45-degree field of view.
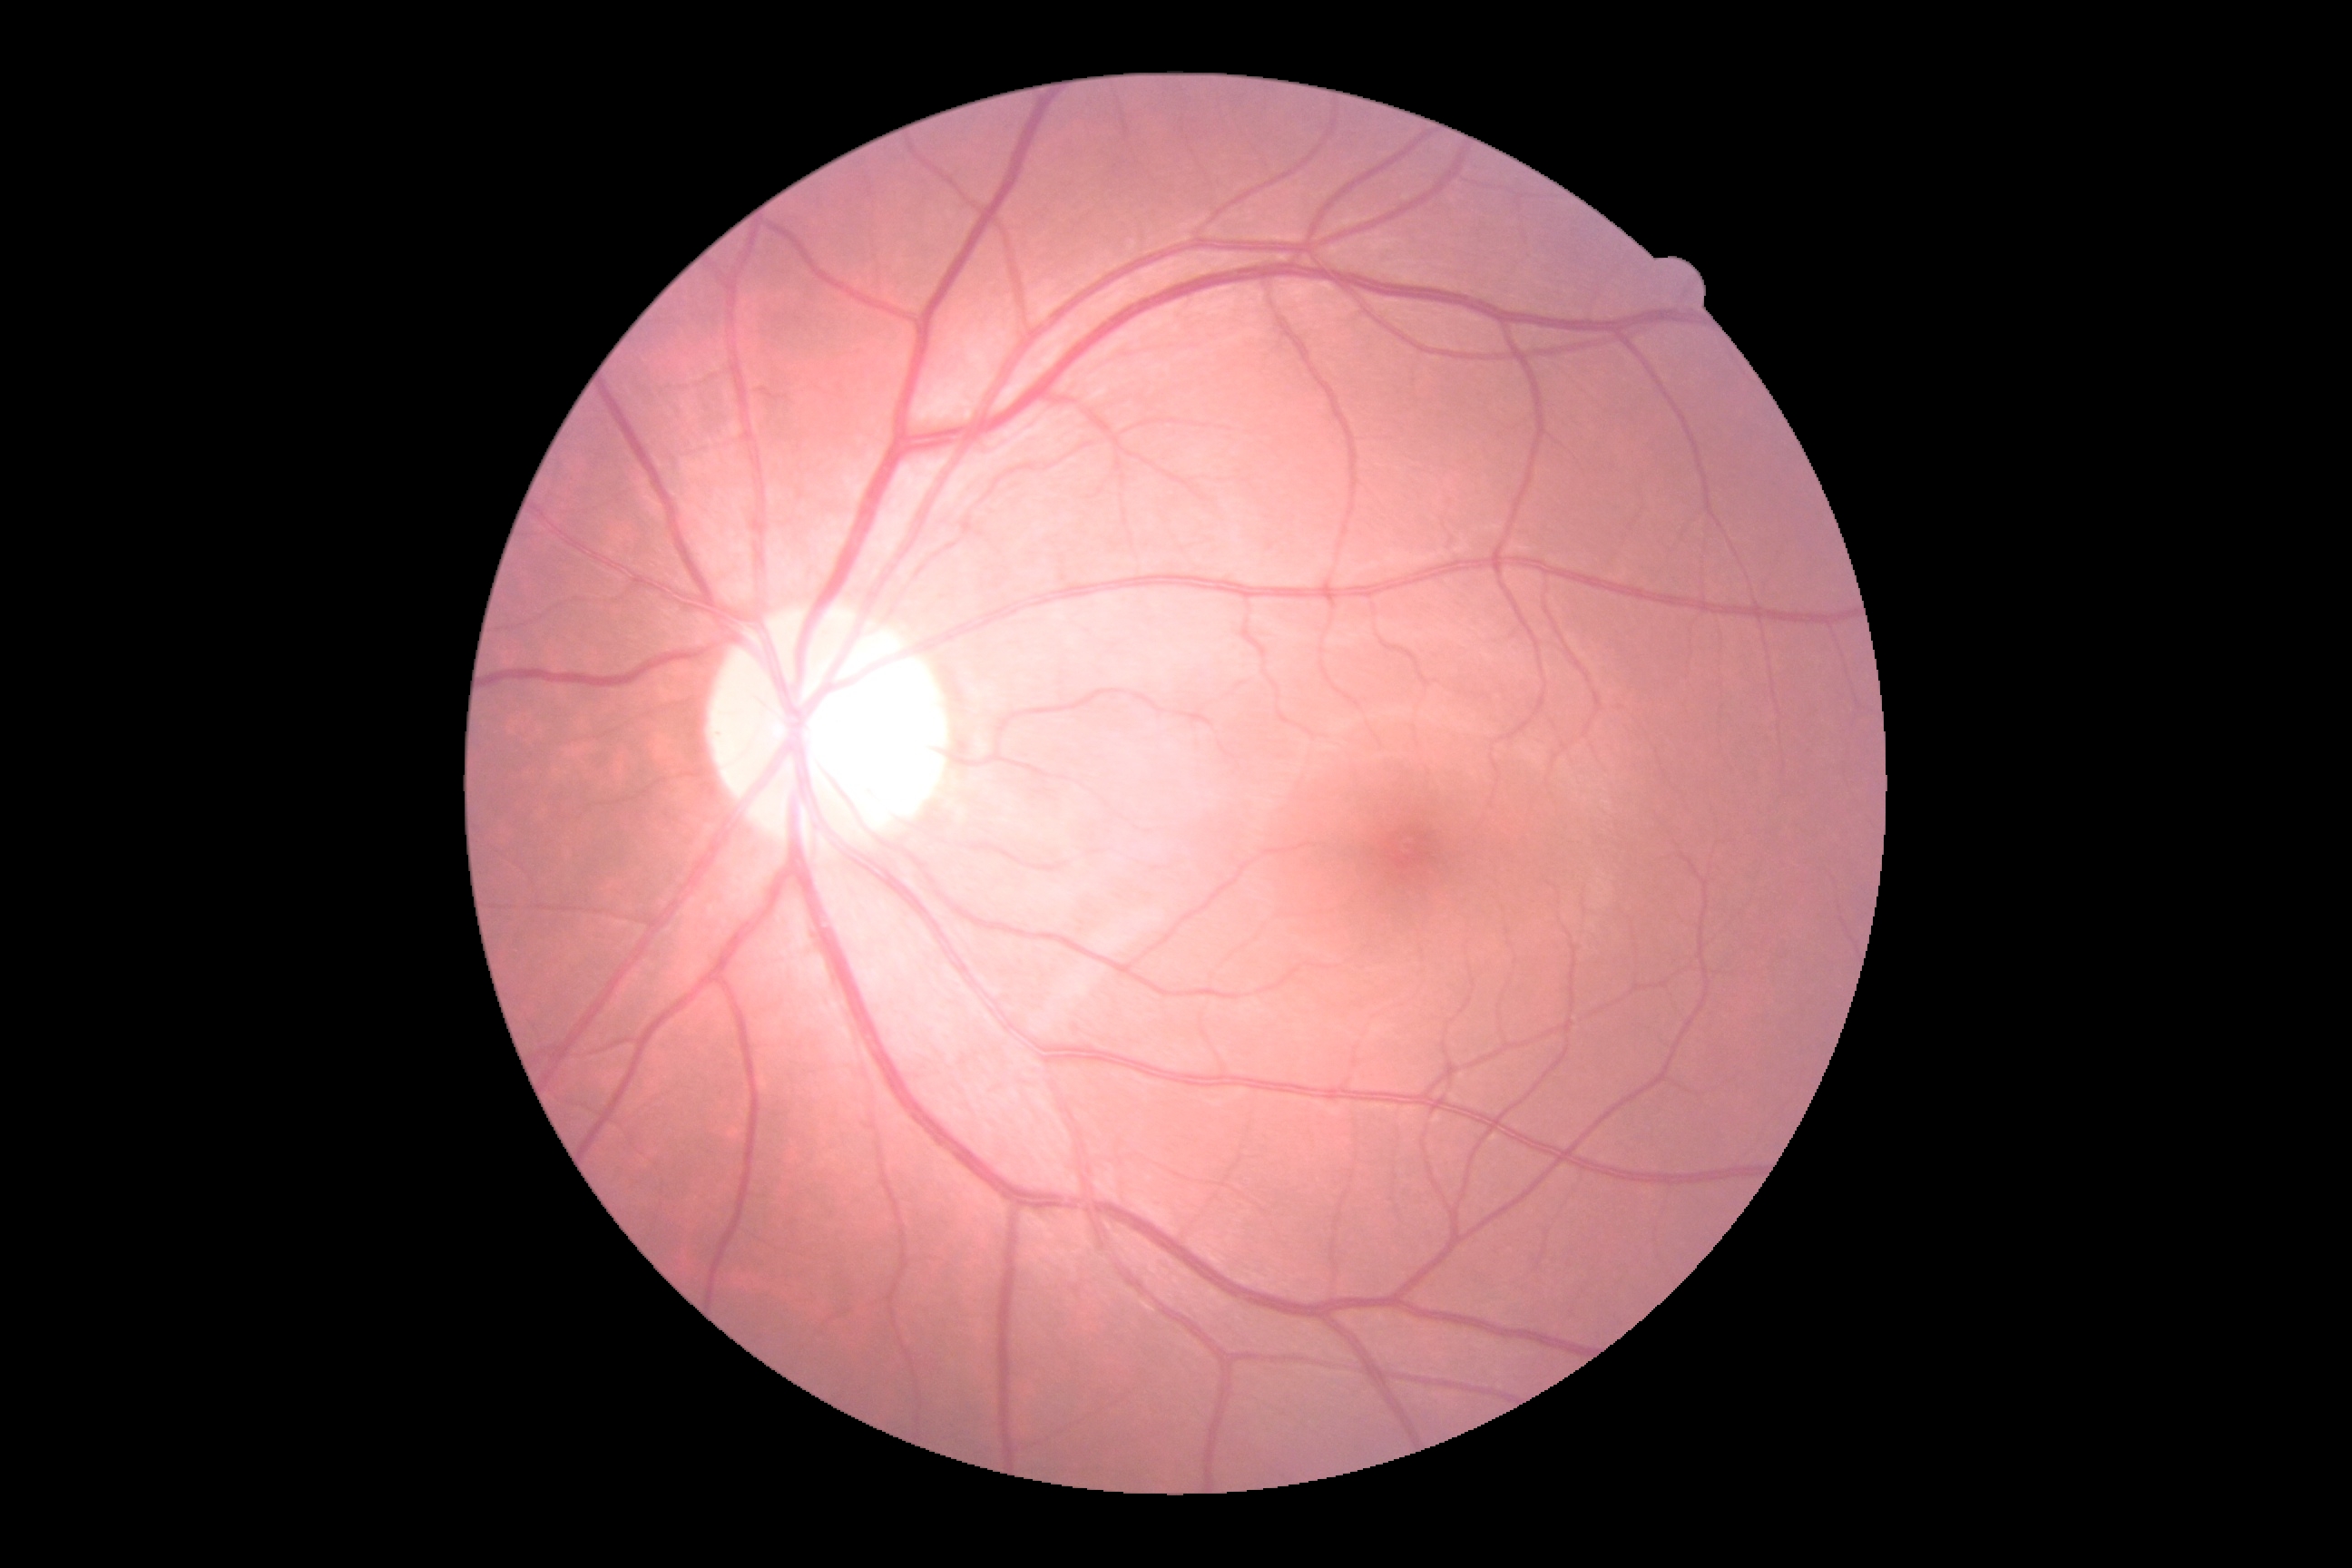
Diabetic retinopathy: 0/4.
No apparent diabetic retinopathy.